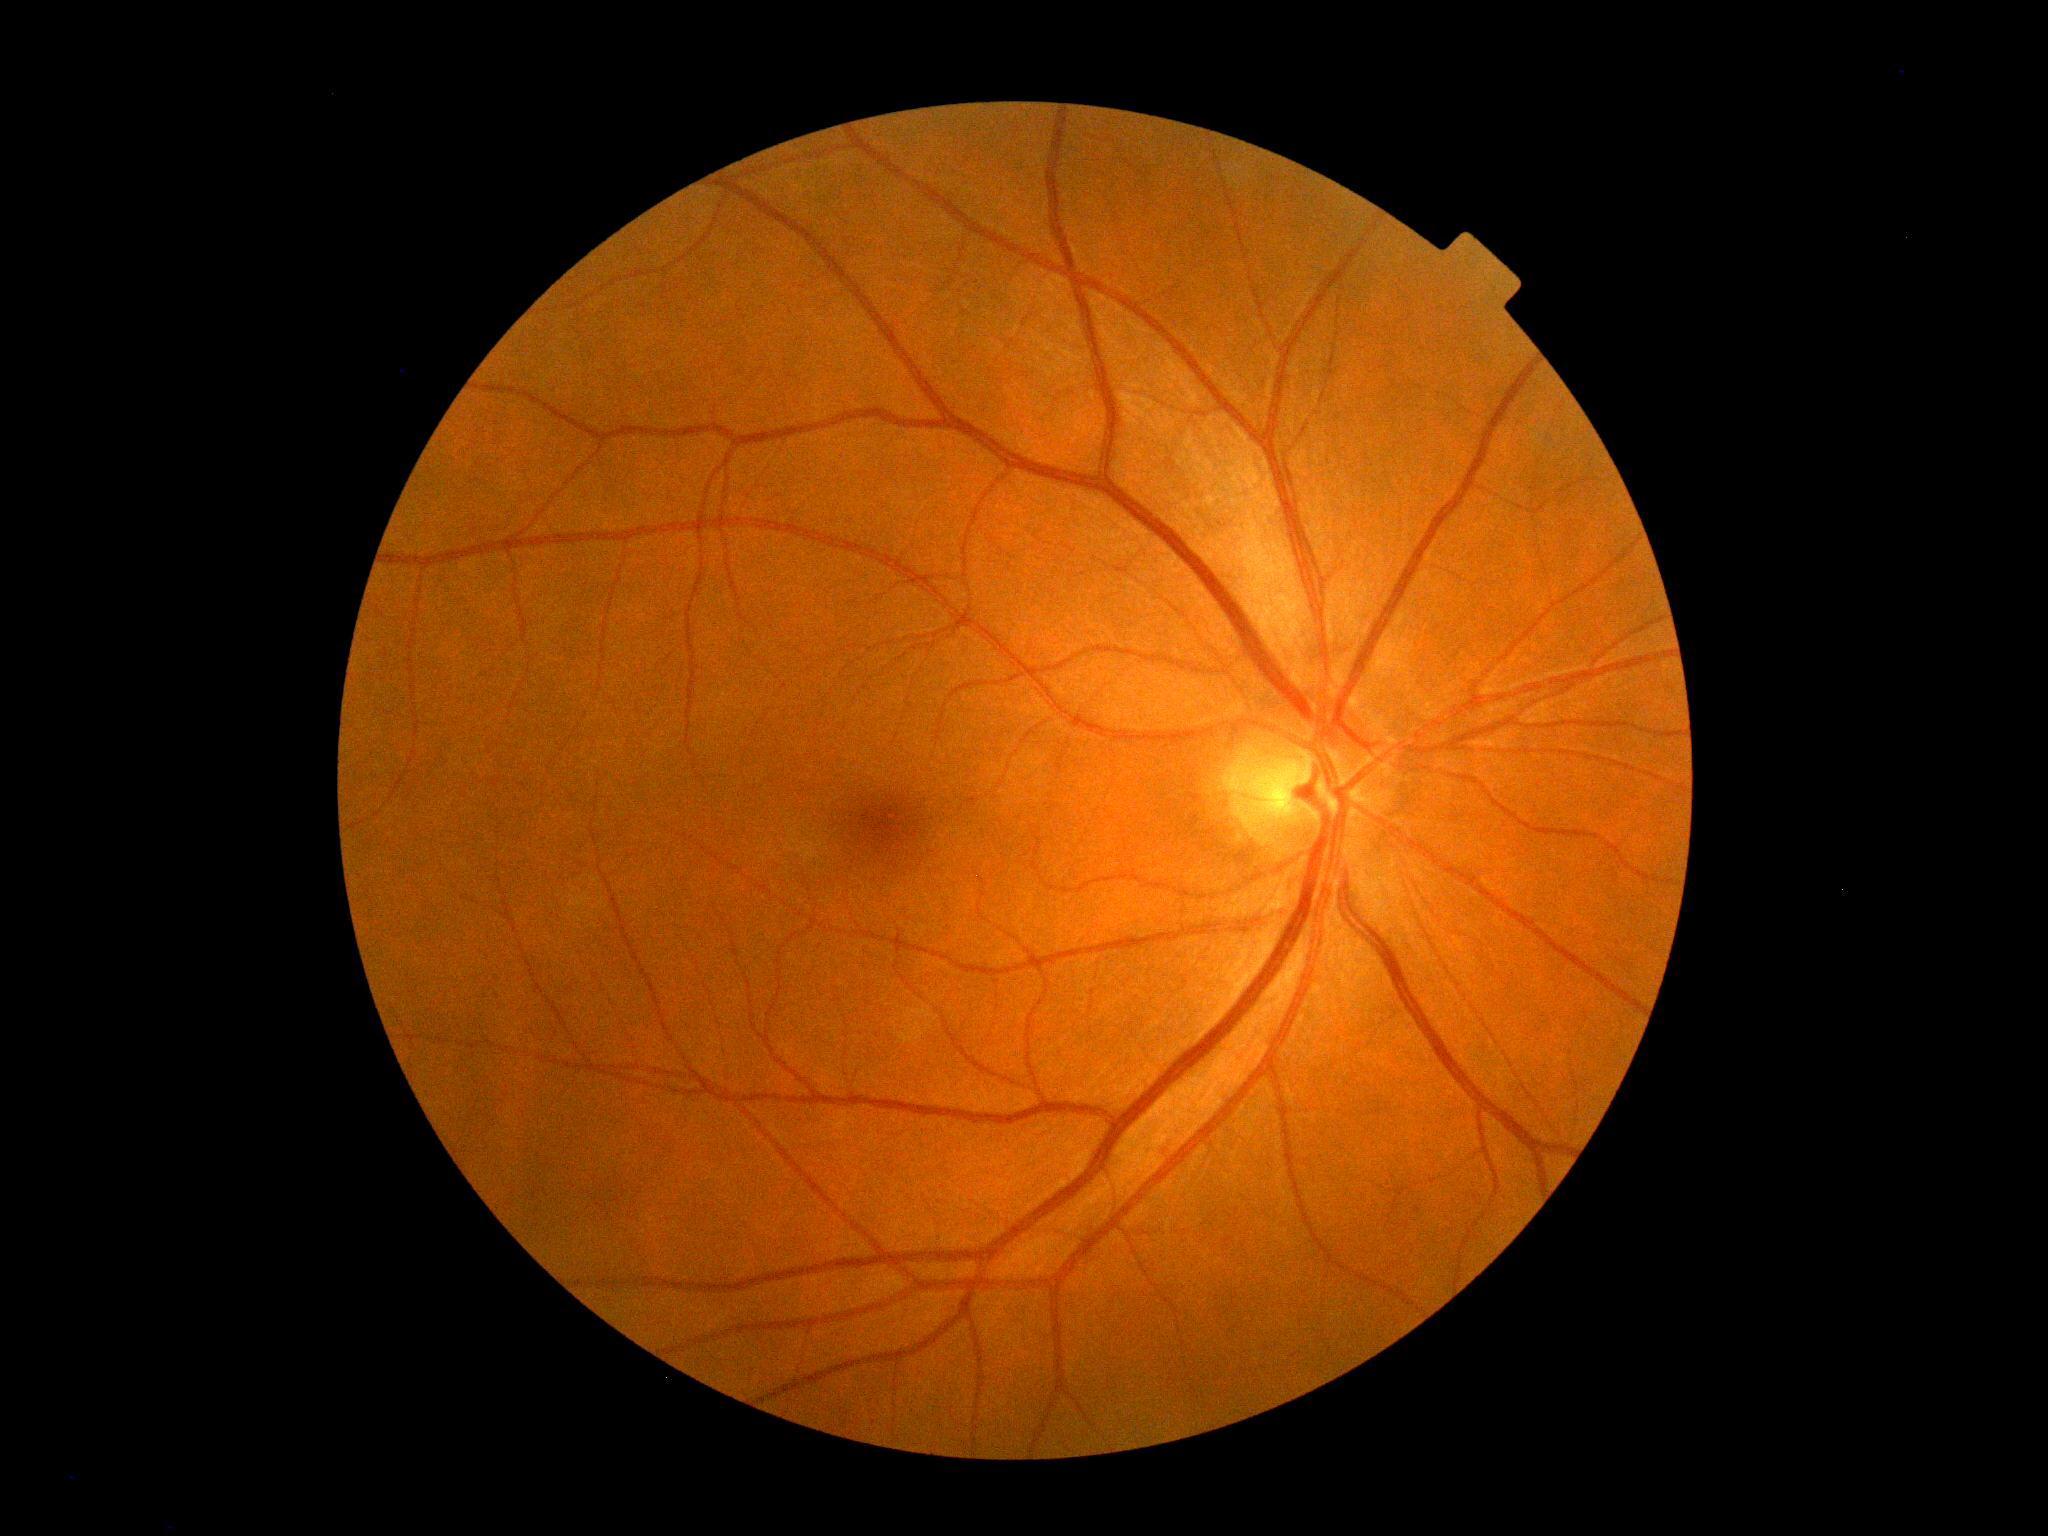 No diabetic retinal disease findings. Diabetic retinopathy severity is grade 0 (no apparent retinopathy).